Natus RetCam Envision, 130° FOV. 1440 by 1080 pixels. Pediatric wide-field fundus photograph — 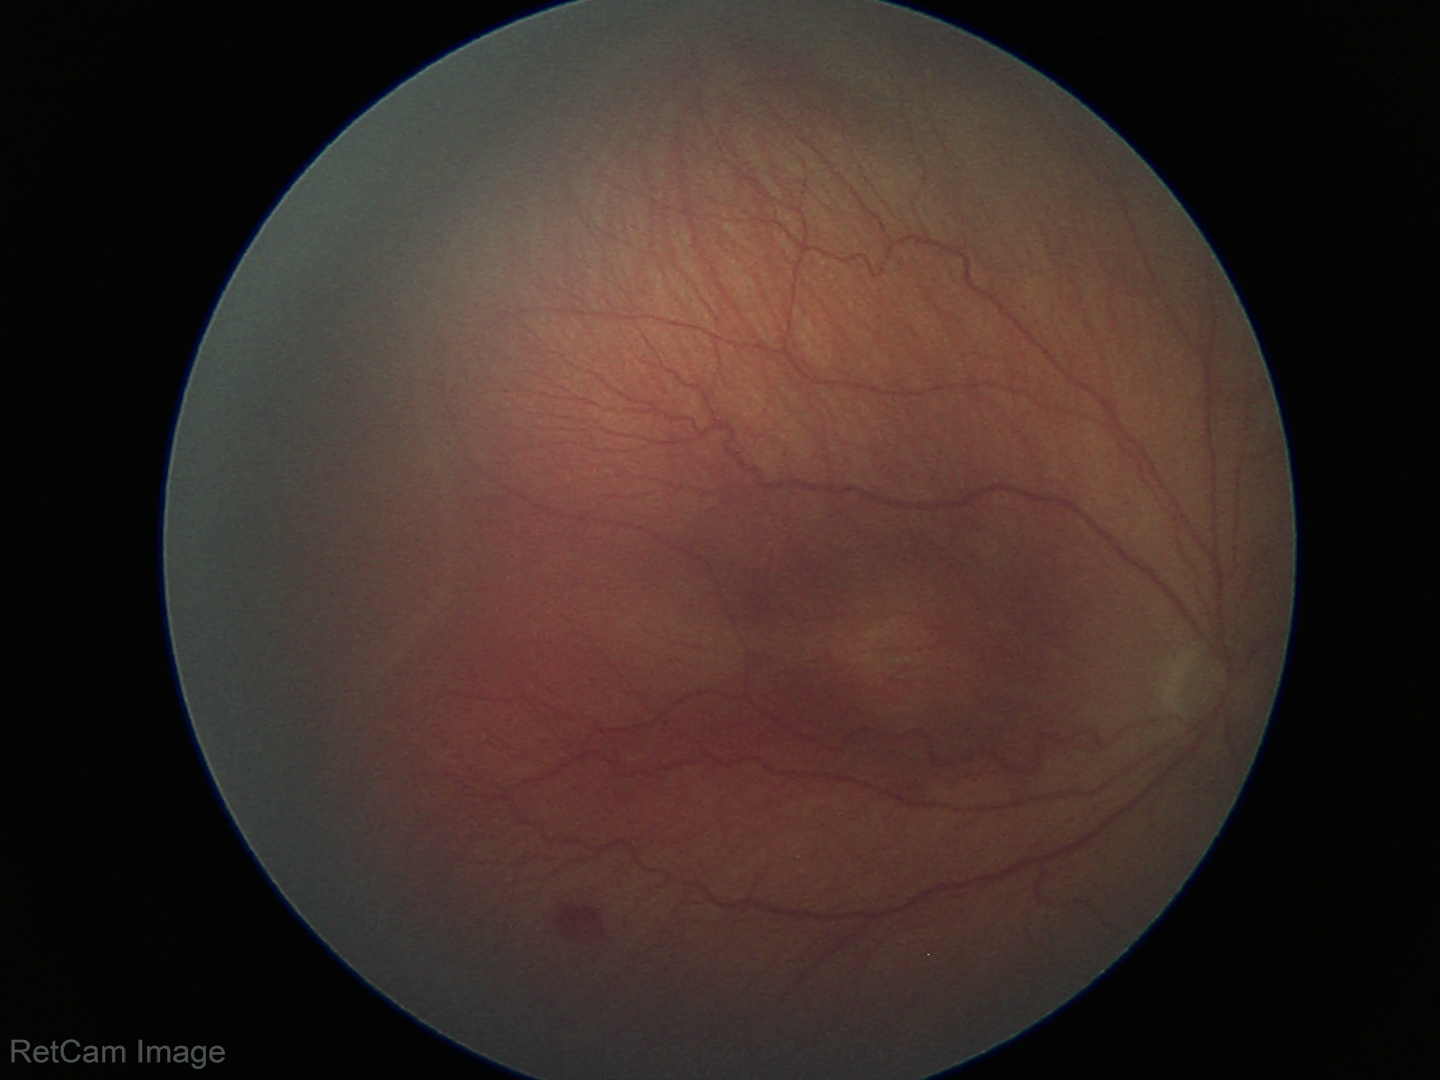
No plus disease. From an examination with diagnosis of ROP stage 3 — ridge with extraretinal fibrovascular proliferation.